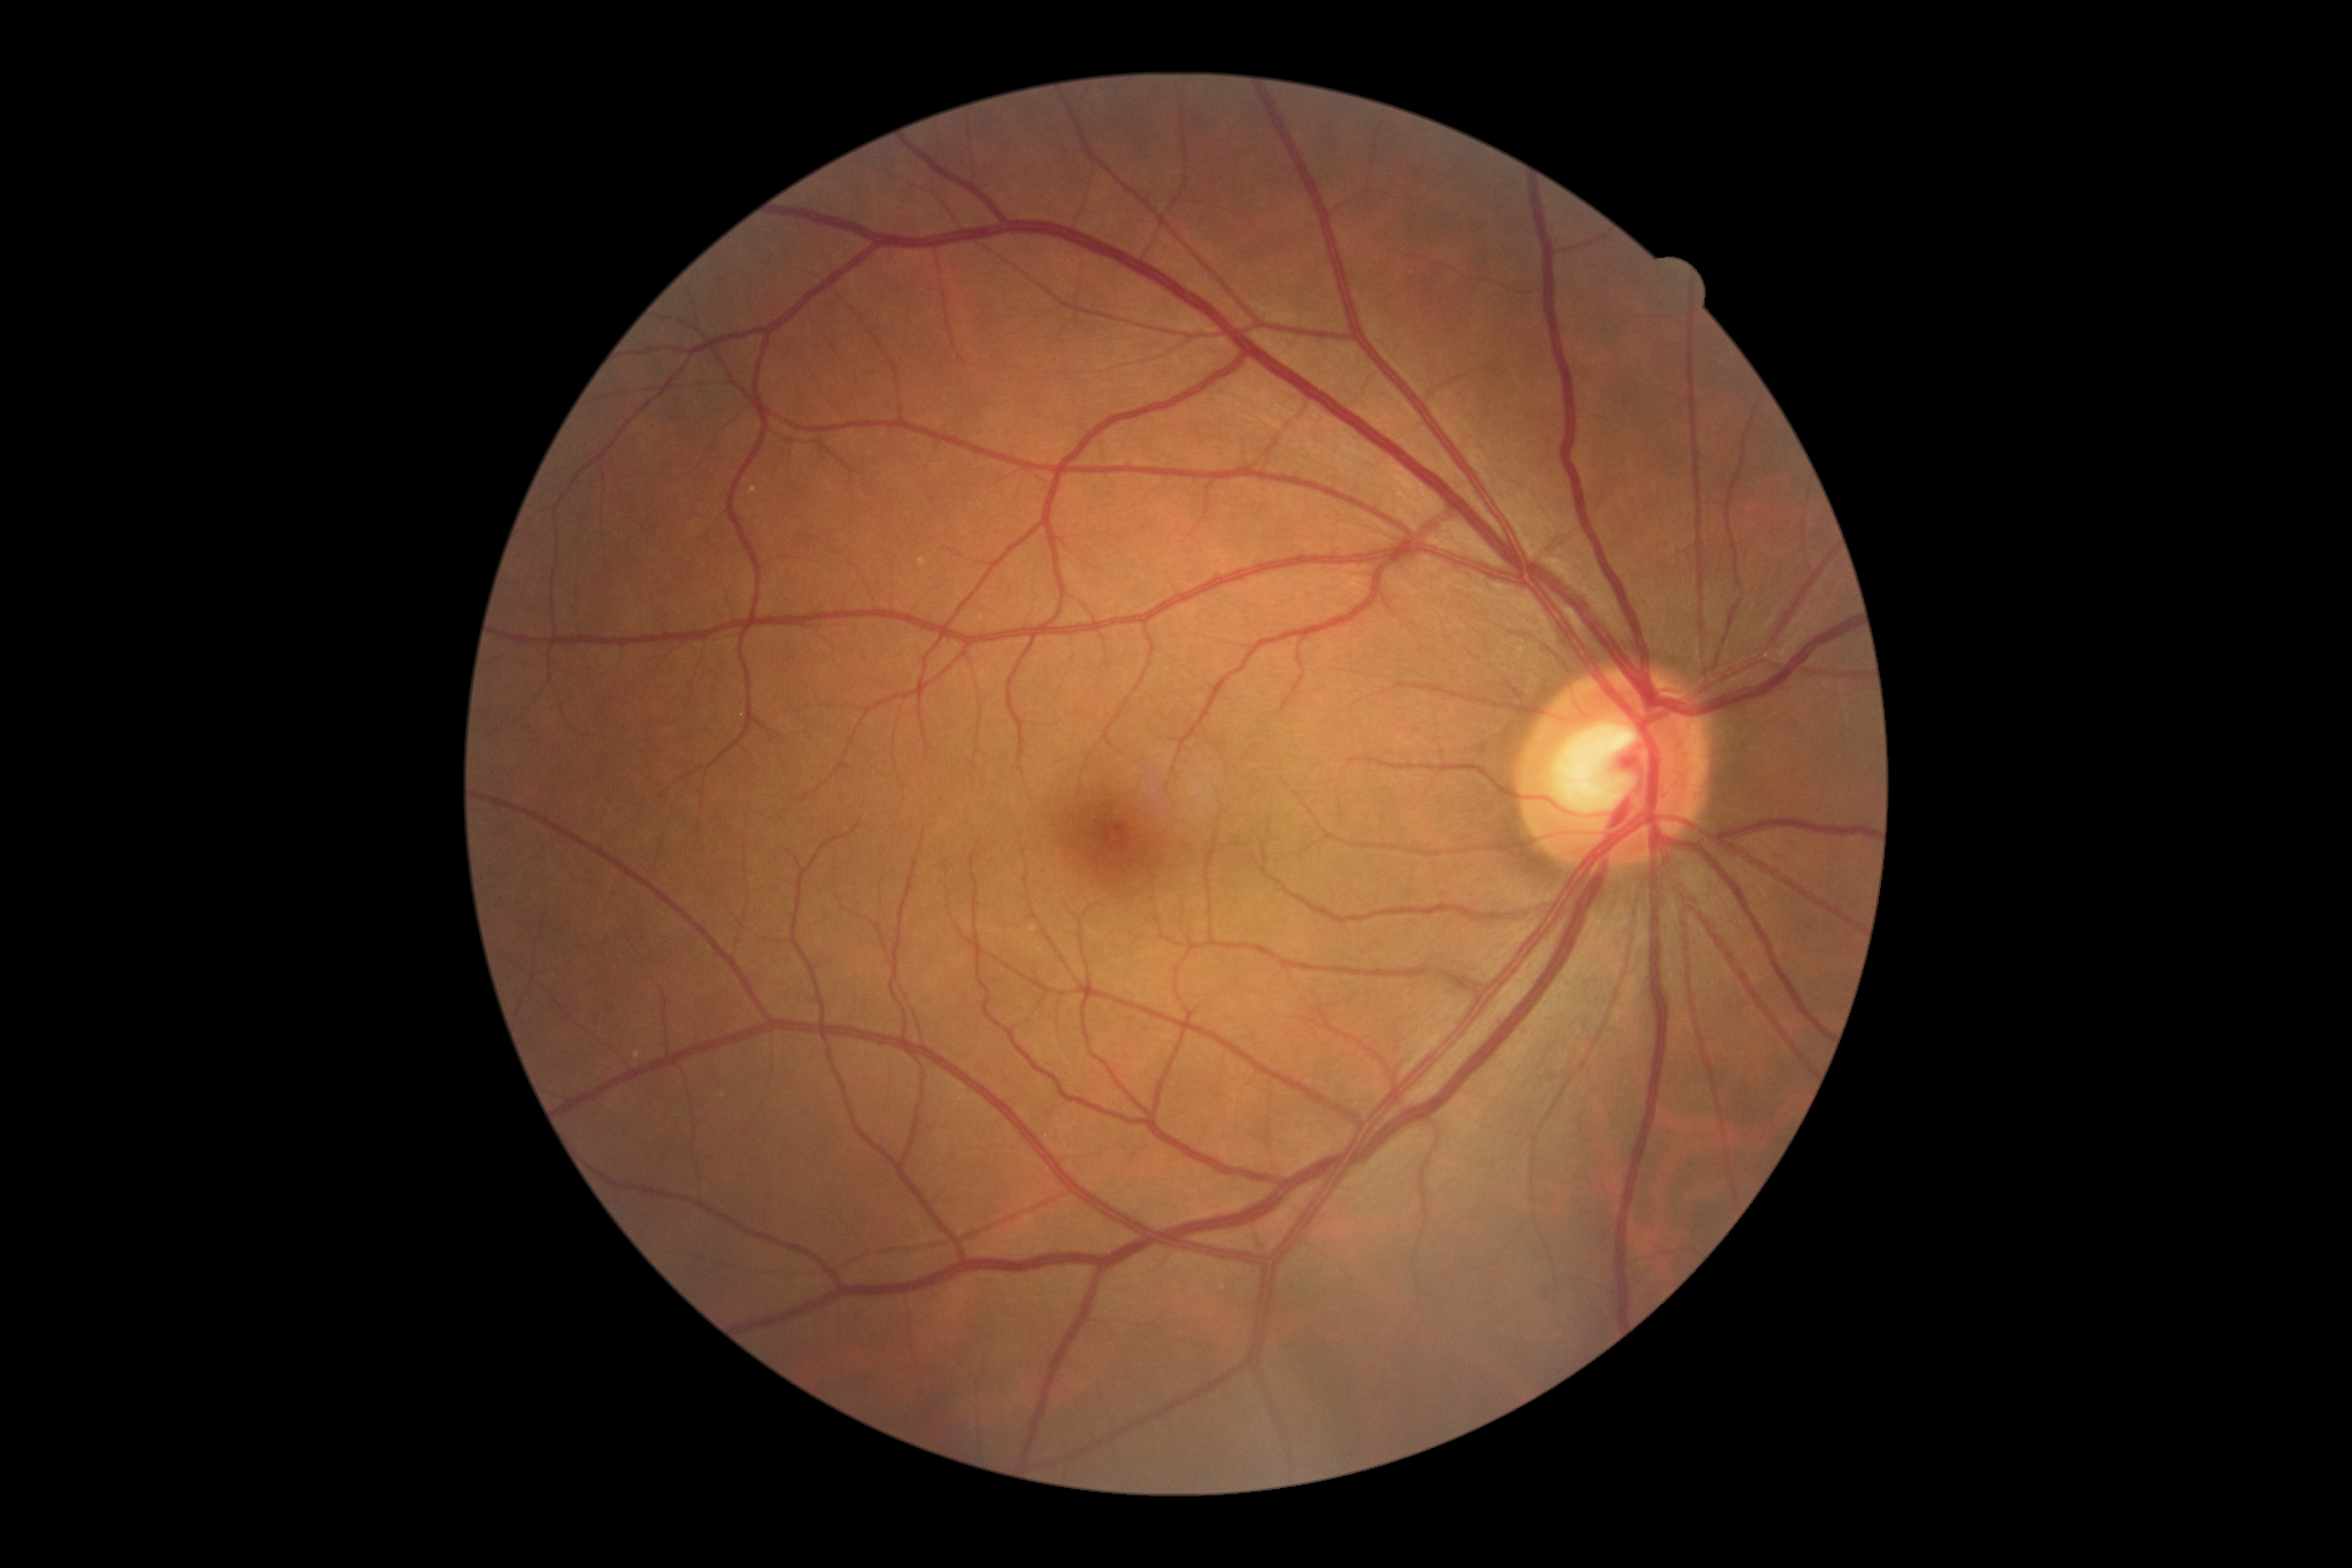

Retinopathy is 0/4. No DR findings.